Pediatric wide-field fundus photograph
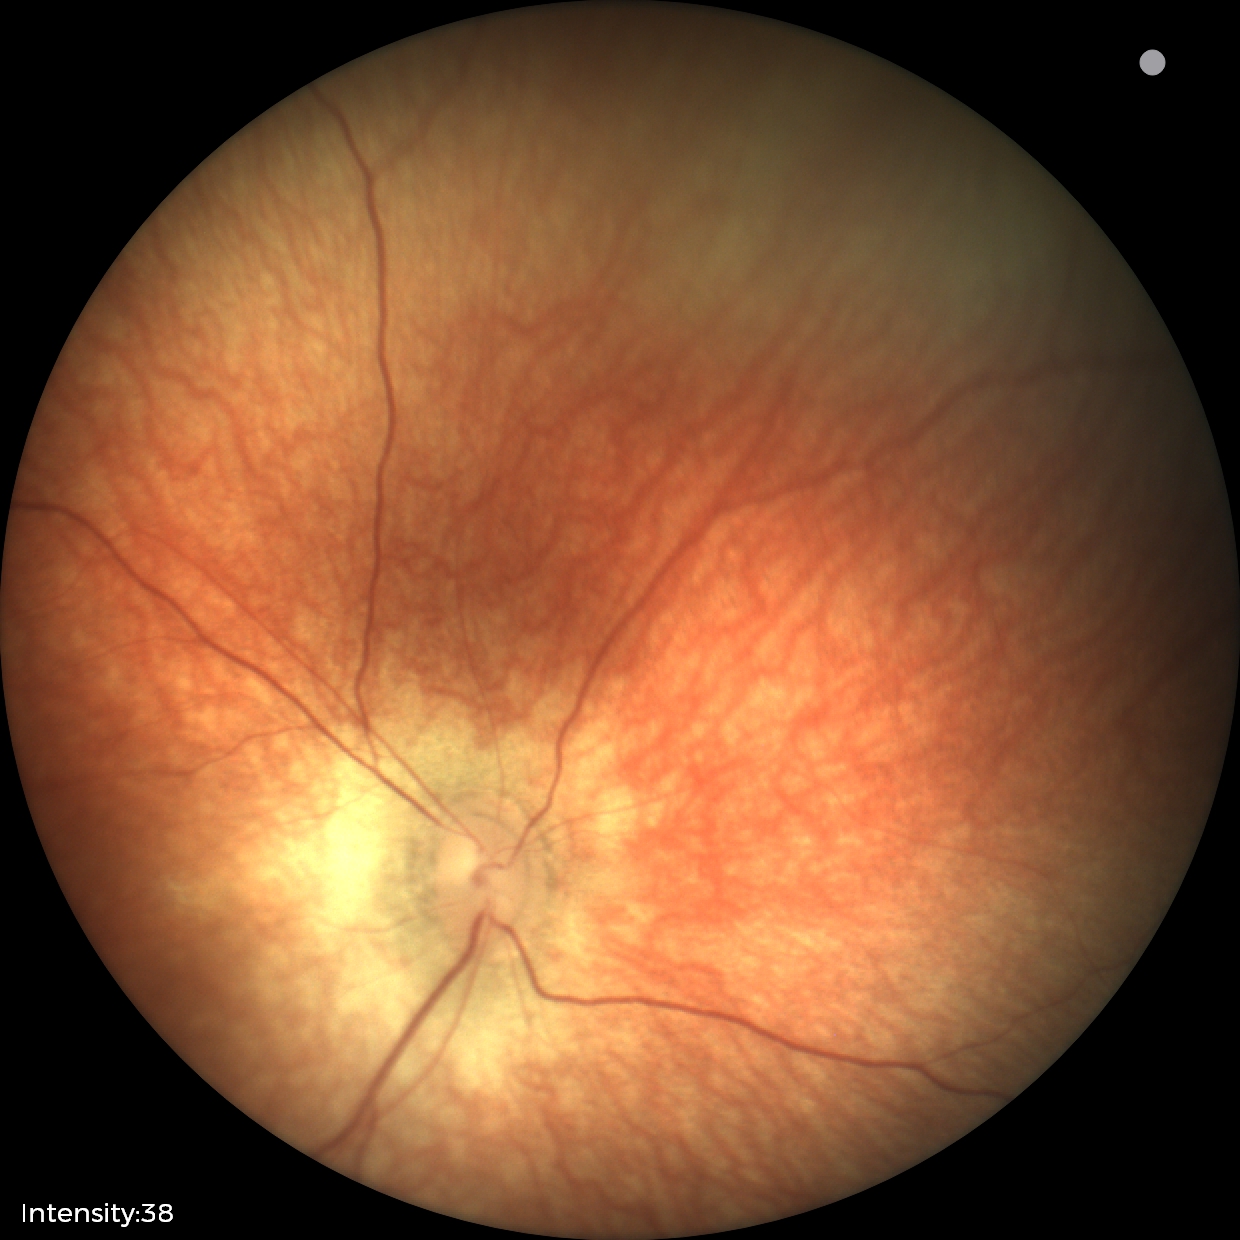 Q: What was the screening finding?
A: physiological retinal finding